Fundus photo. 45° field of view.
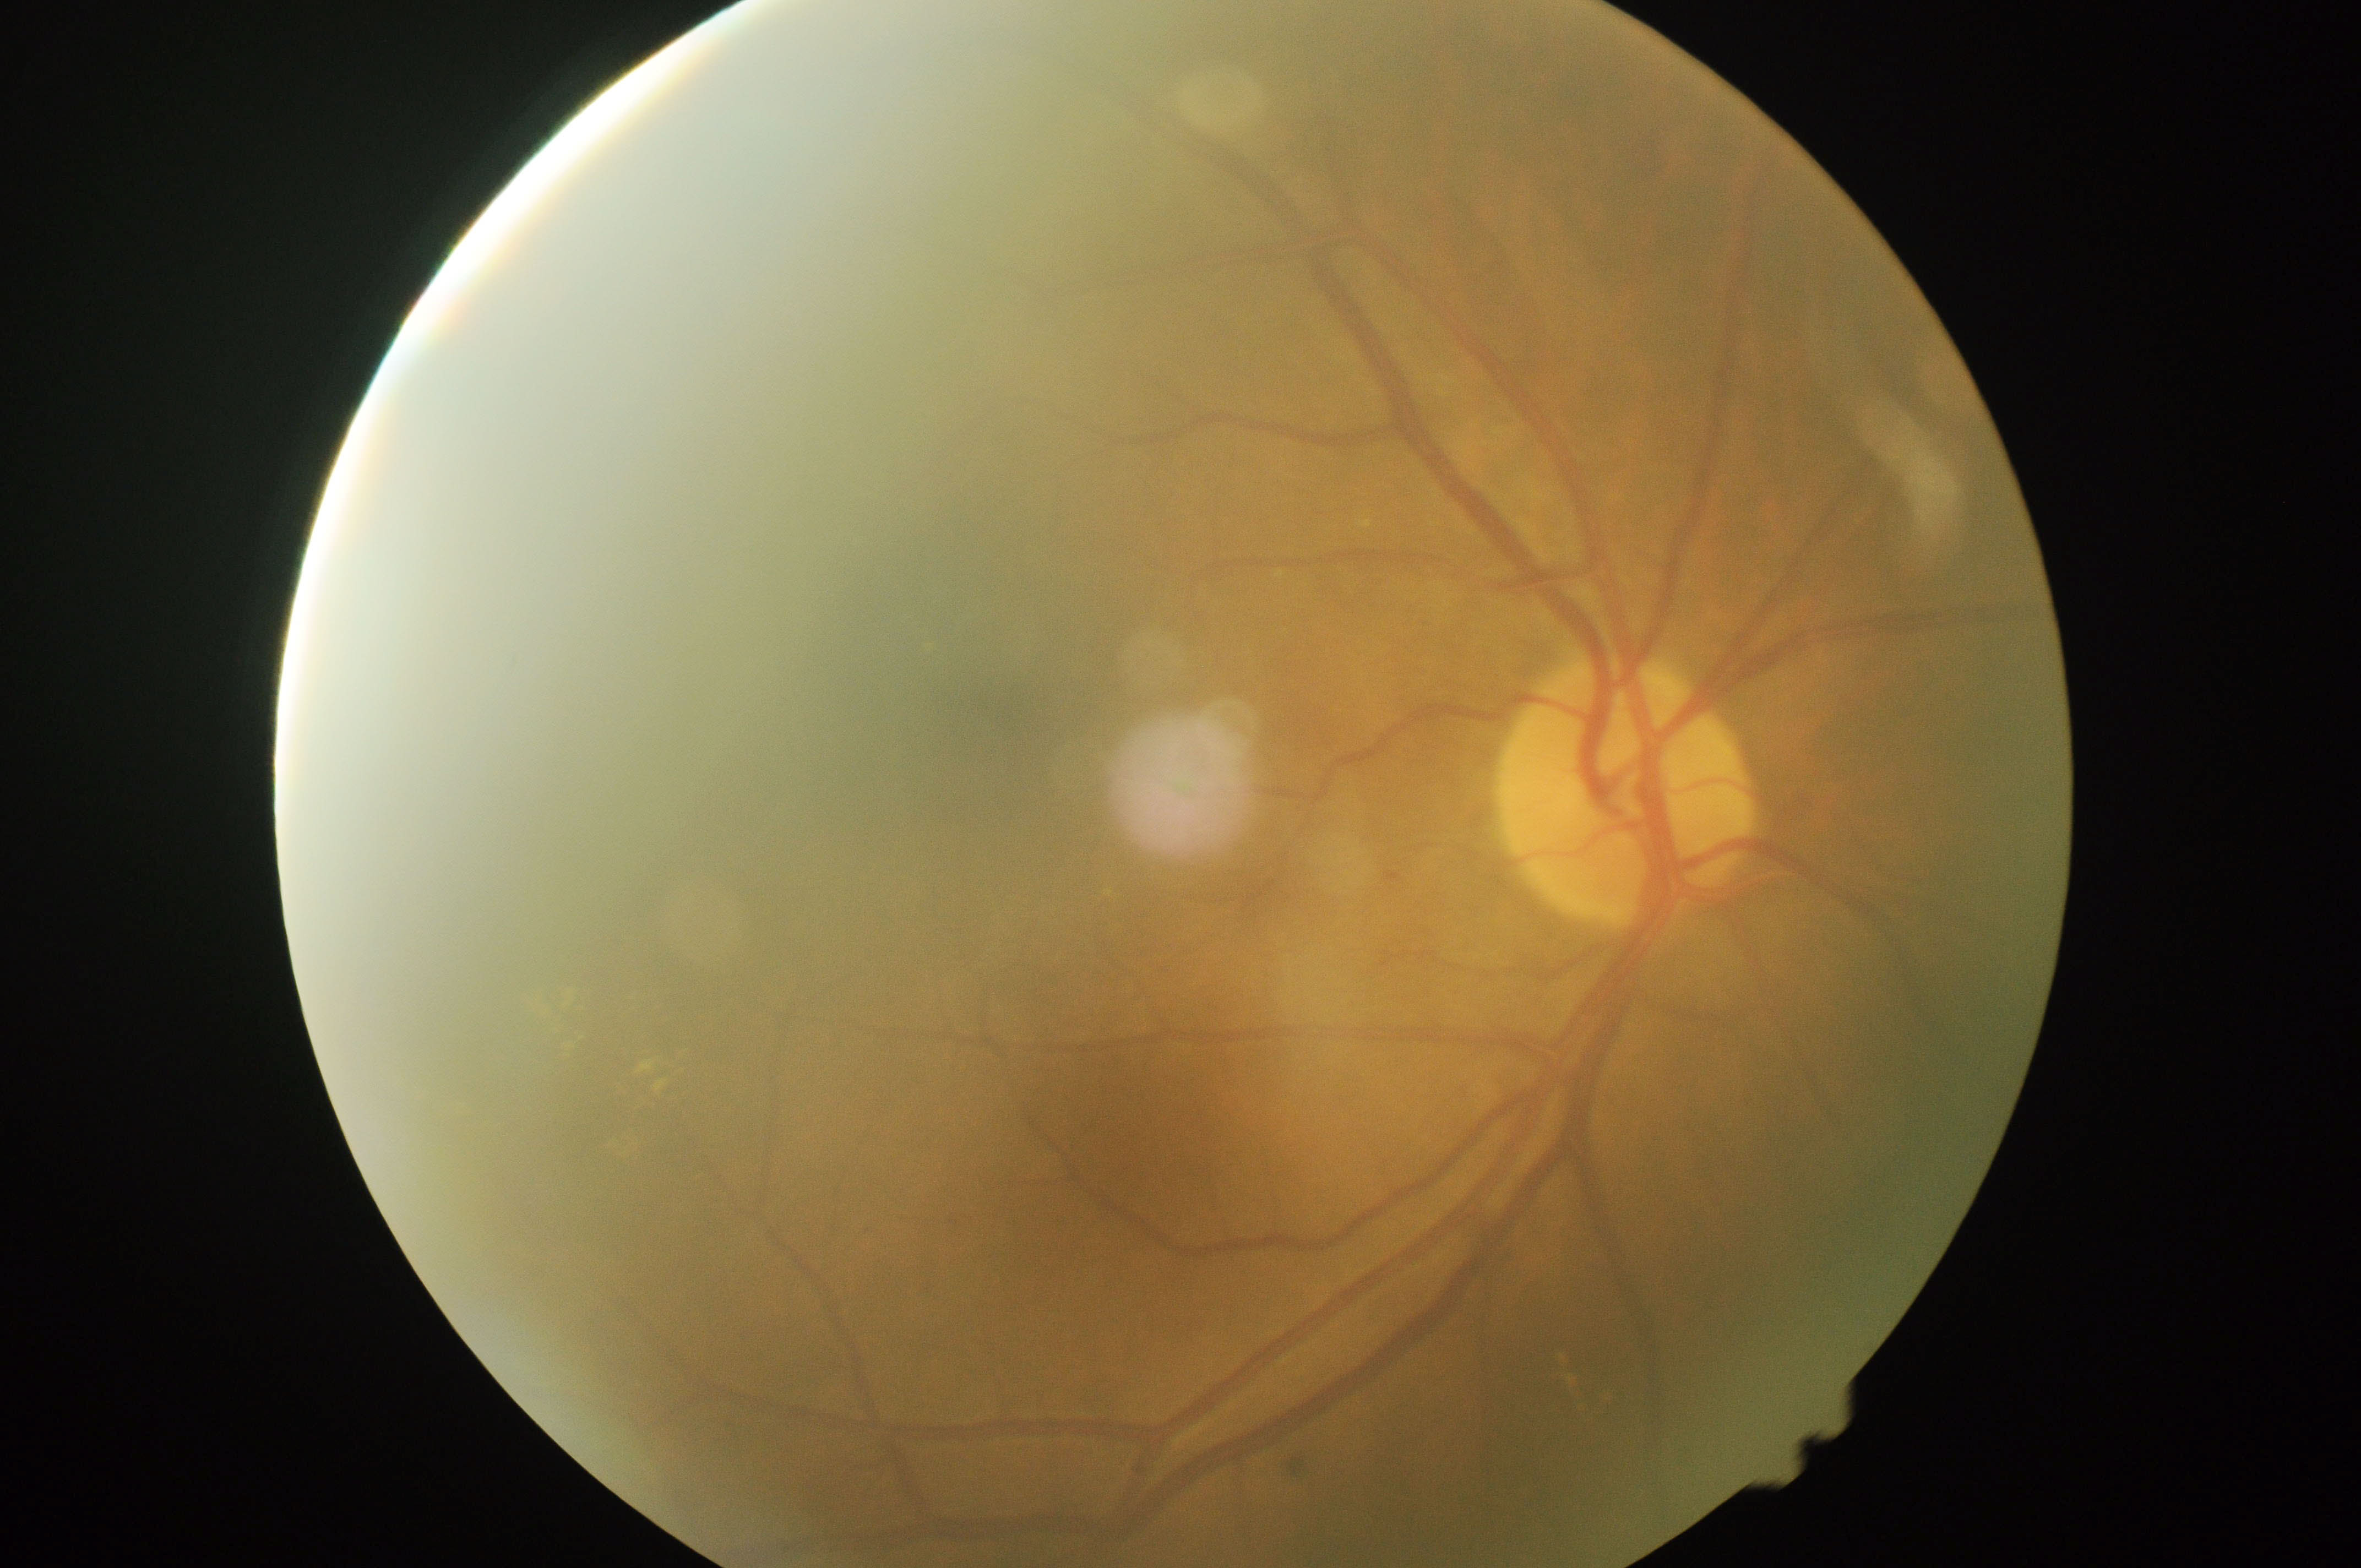 Disease class: non-proliferative diabetic retinopathy. DR grade: 2.